DR severity per modified Davis staging: 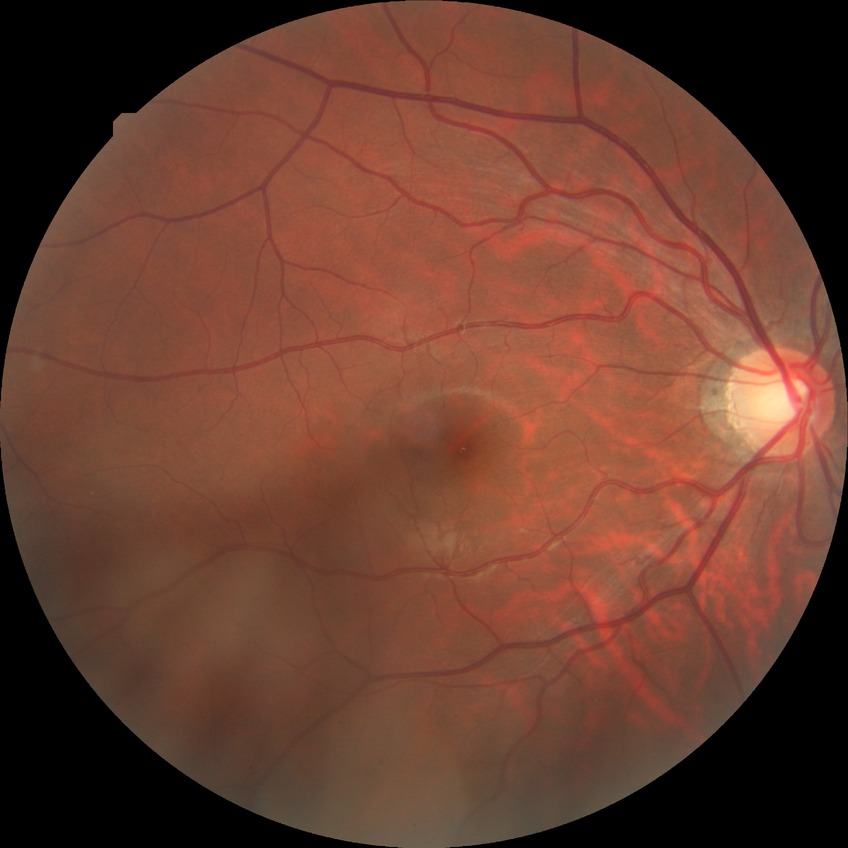 Diabetic retinopathy (DR): NDR (no diabetic retinopathy).